Wide-field fundus image from infant ROP screening · captured with the Clarity RetCam 3 (130° field of view).
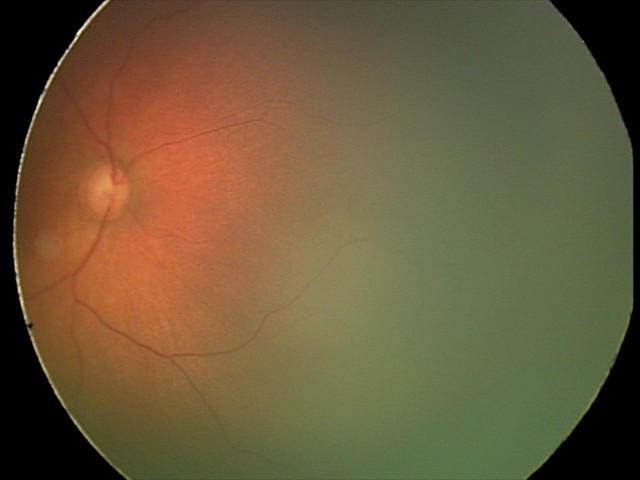

Assessment: physiological finding.